Color fundus image · Davis DR grading · FOV: 45 degrees · no pharmacologic dilation:
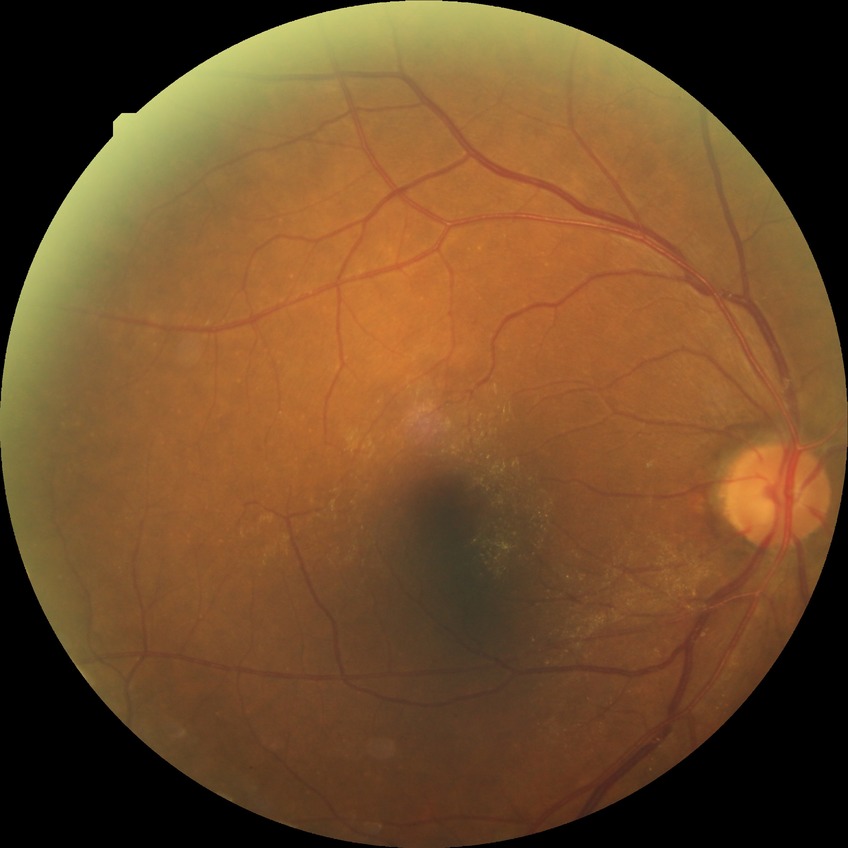
Findings:
* DR severity — SDR